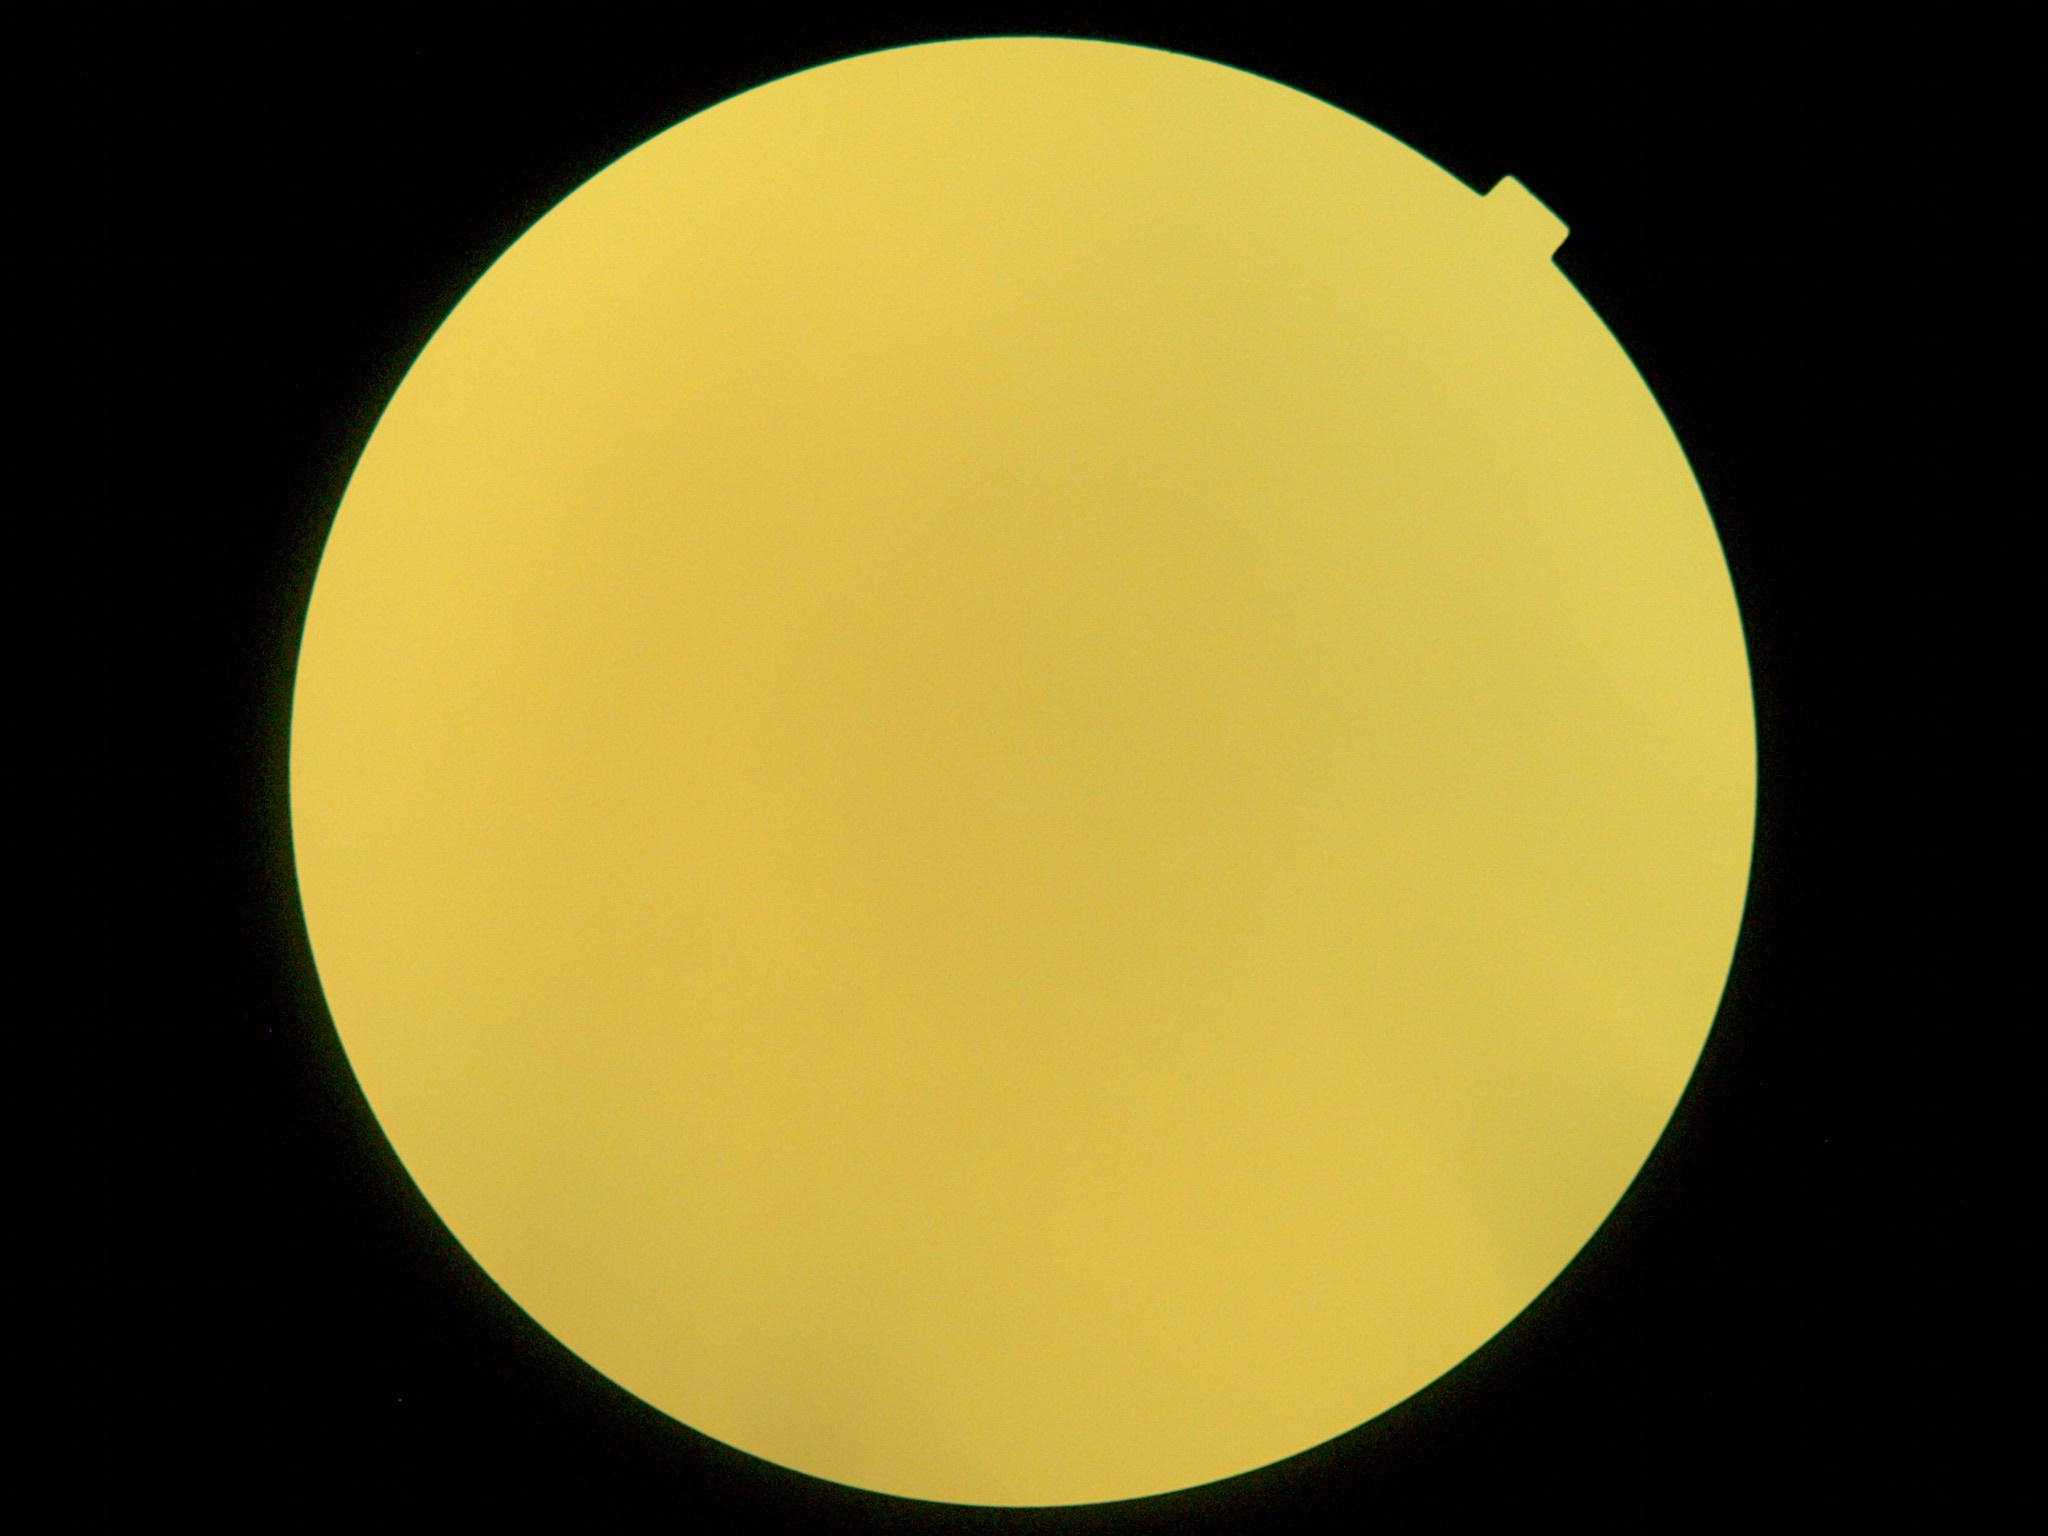
diabetic retinopathy (DR) = ungradable due to poor image quality.